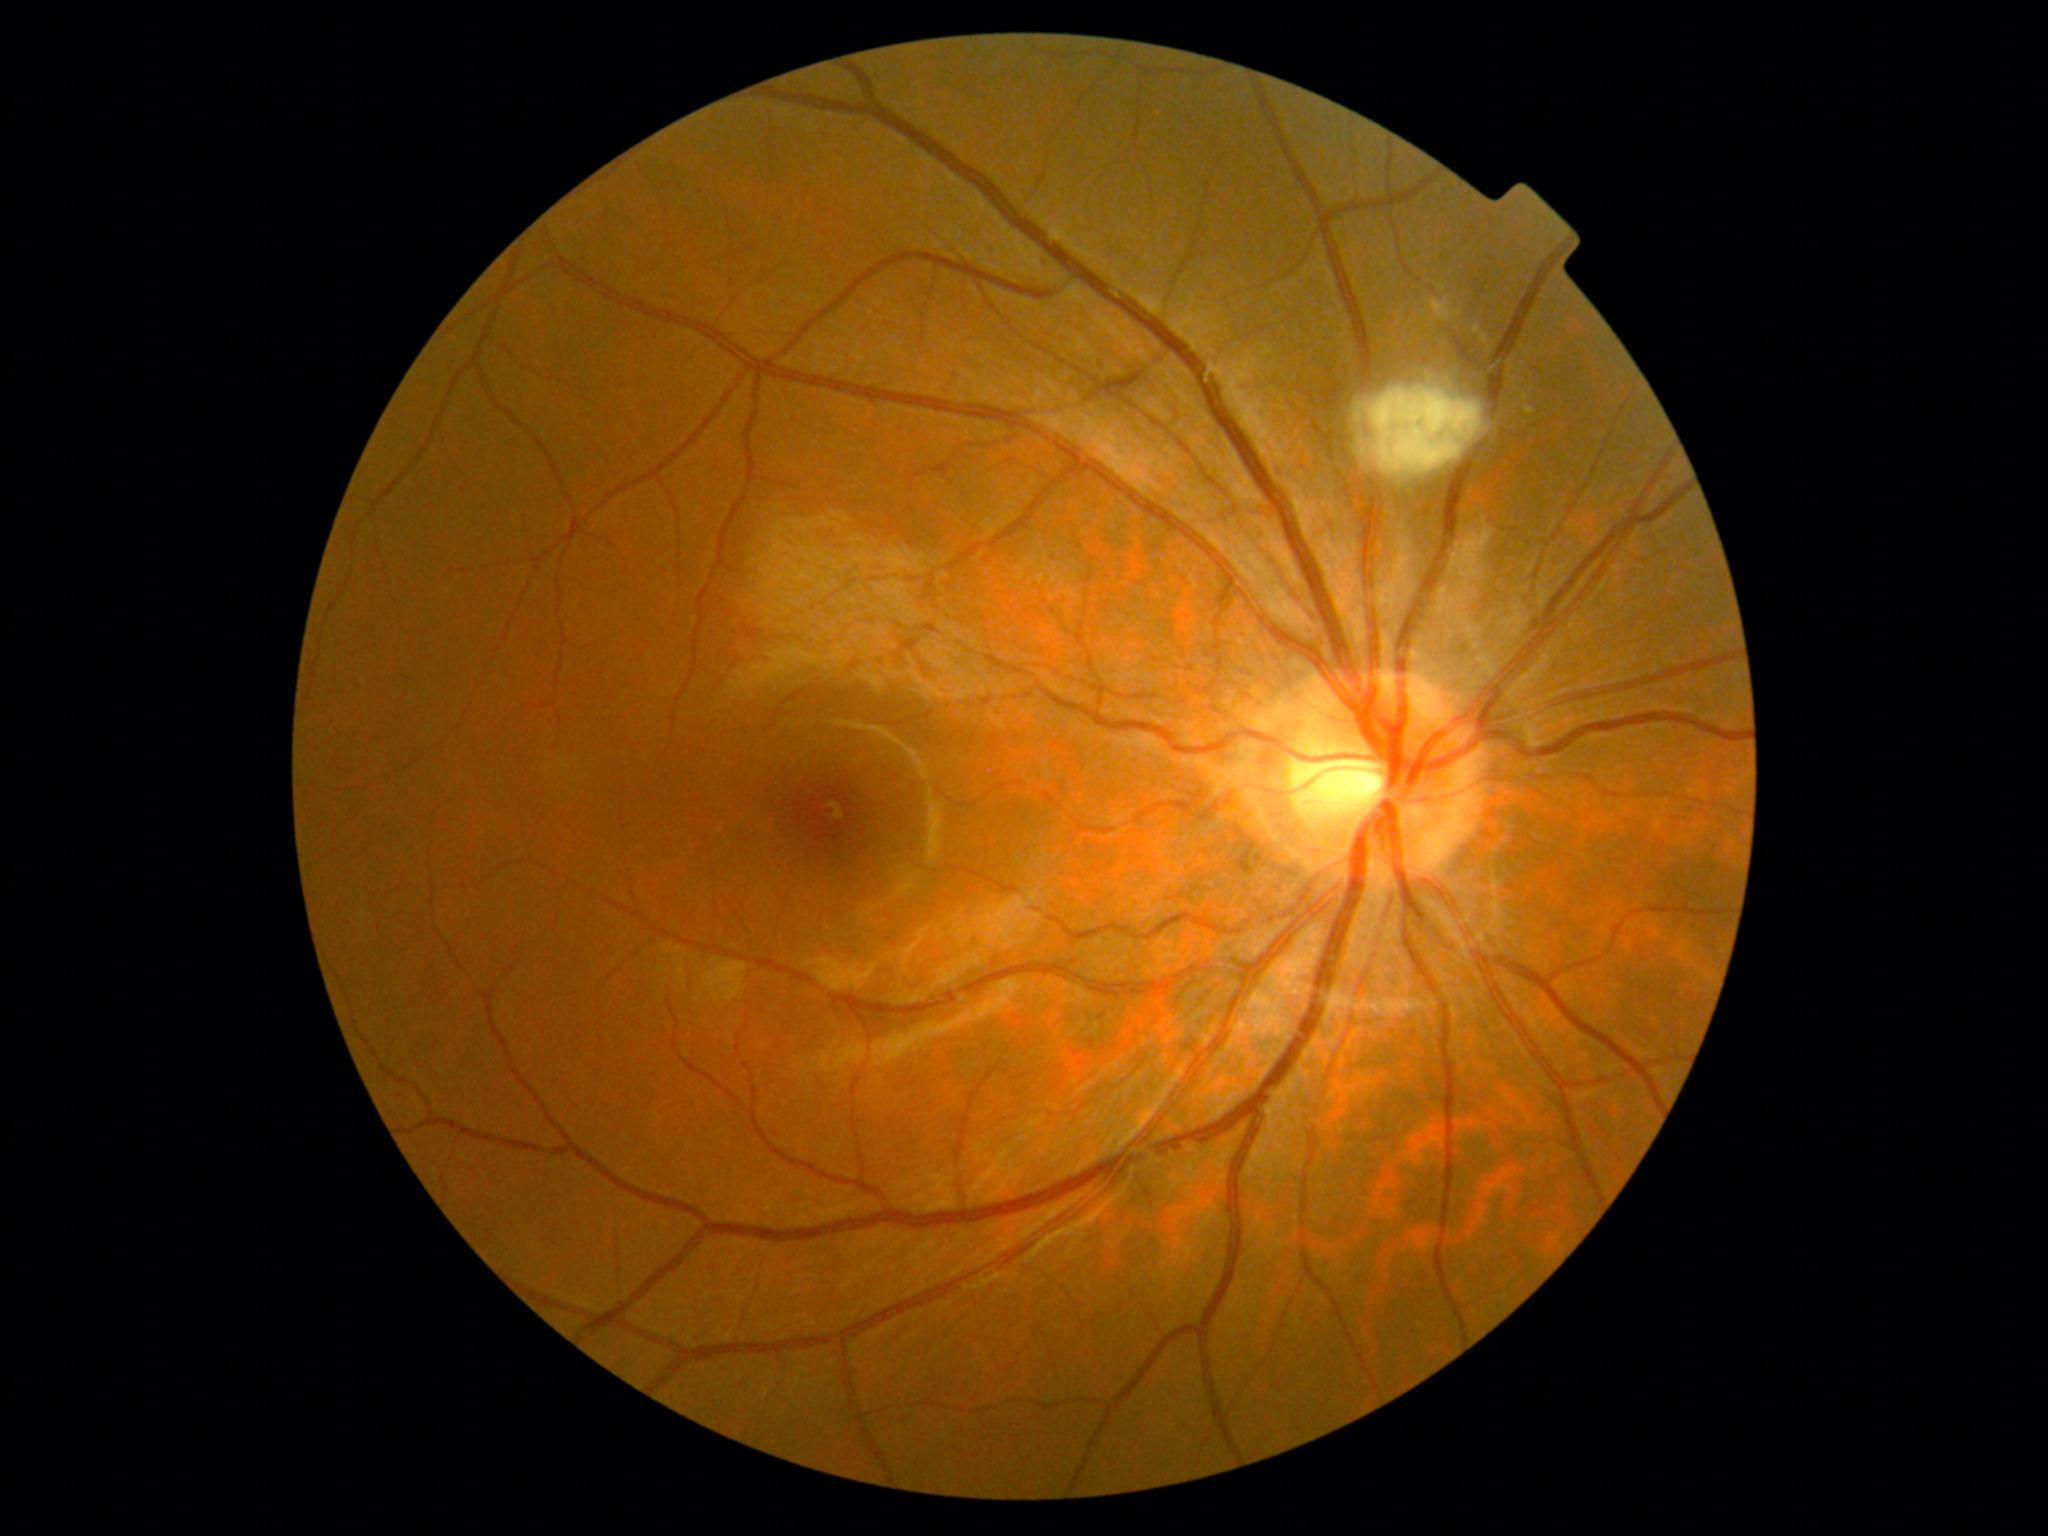

Diabetic retinopathy (DR) is grade 2 — more than just microaneurysms but less than severe NPDR. The retinopathy is classified as non-proliferative diabetic retinopathy.